240 by 240 pixels
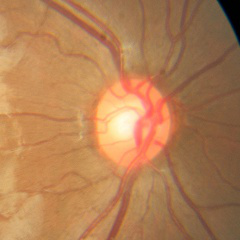
Q: What stage of glaucoma is present?
A: No glaucomatous changes.